1936x1296px.
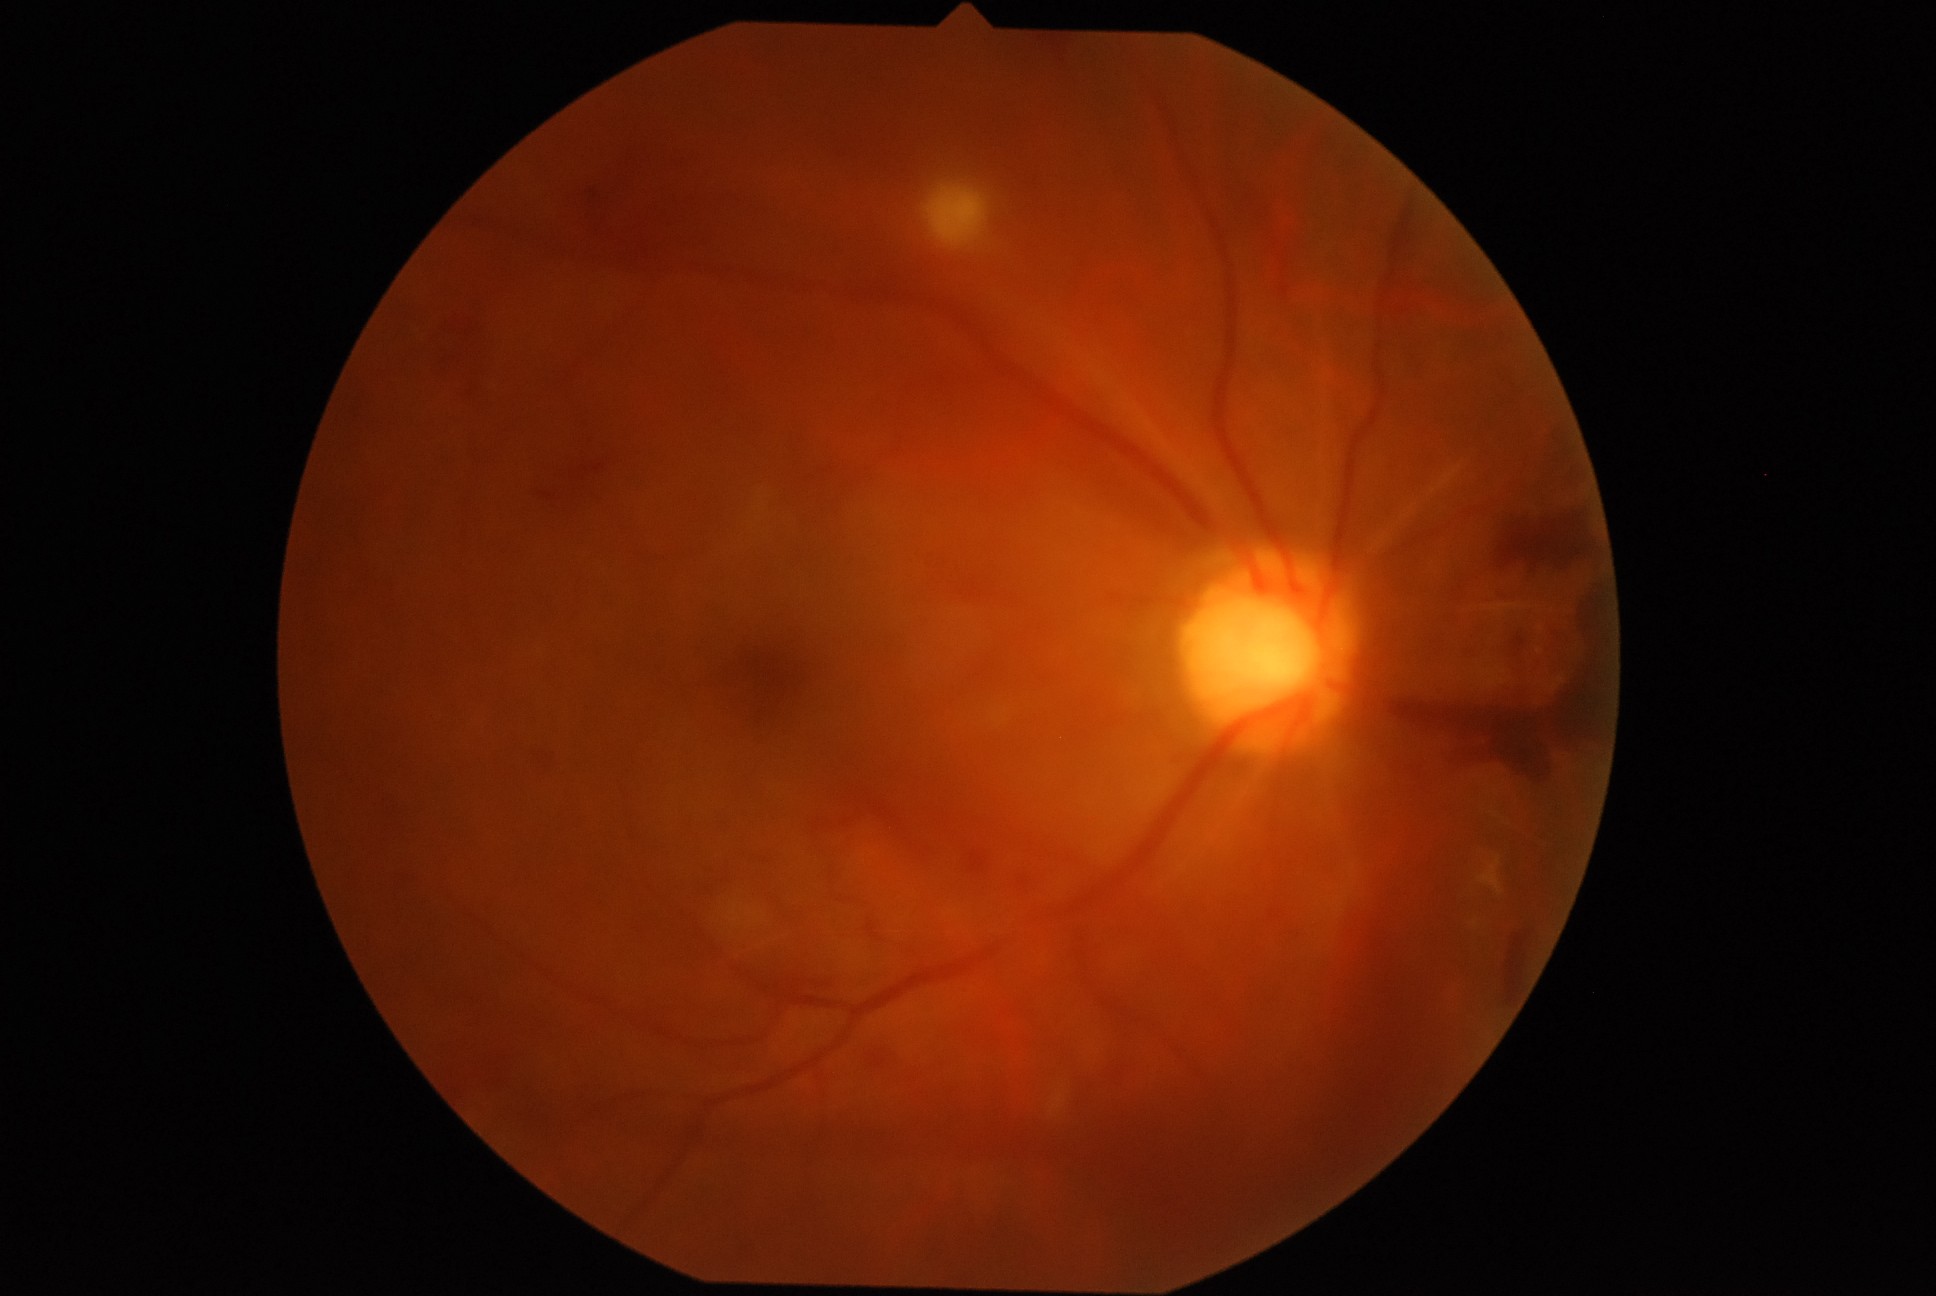 DR is grade 4.